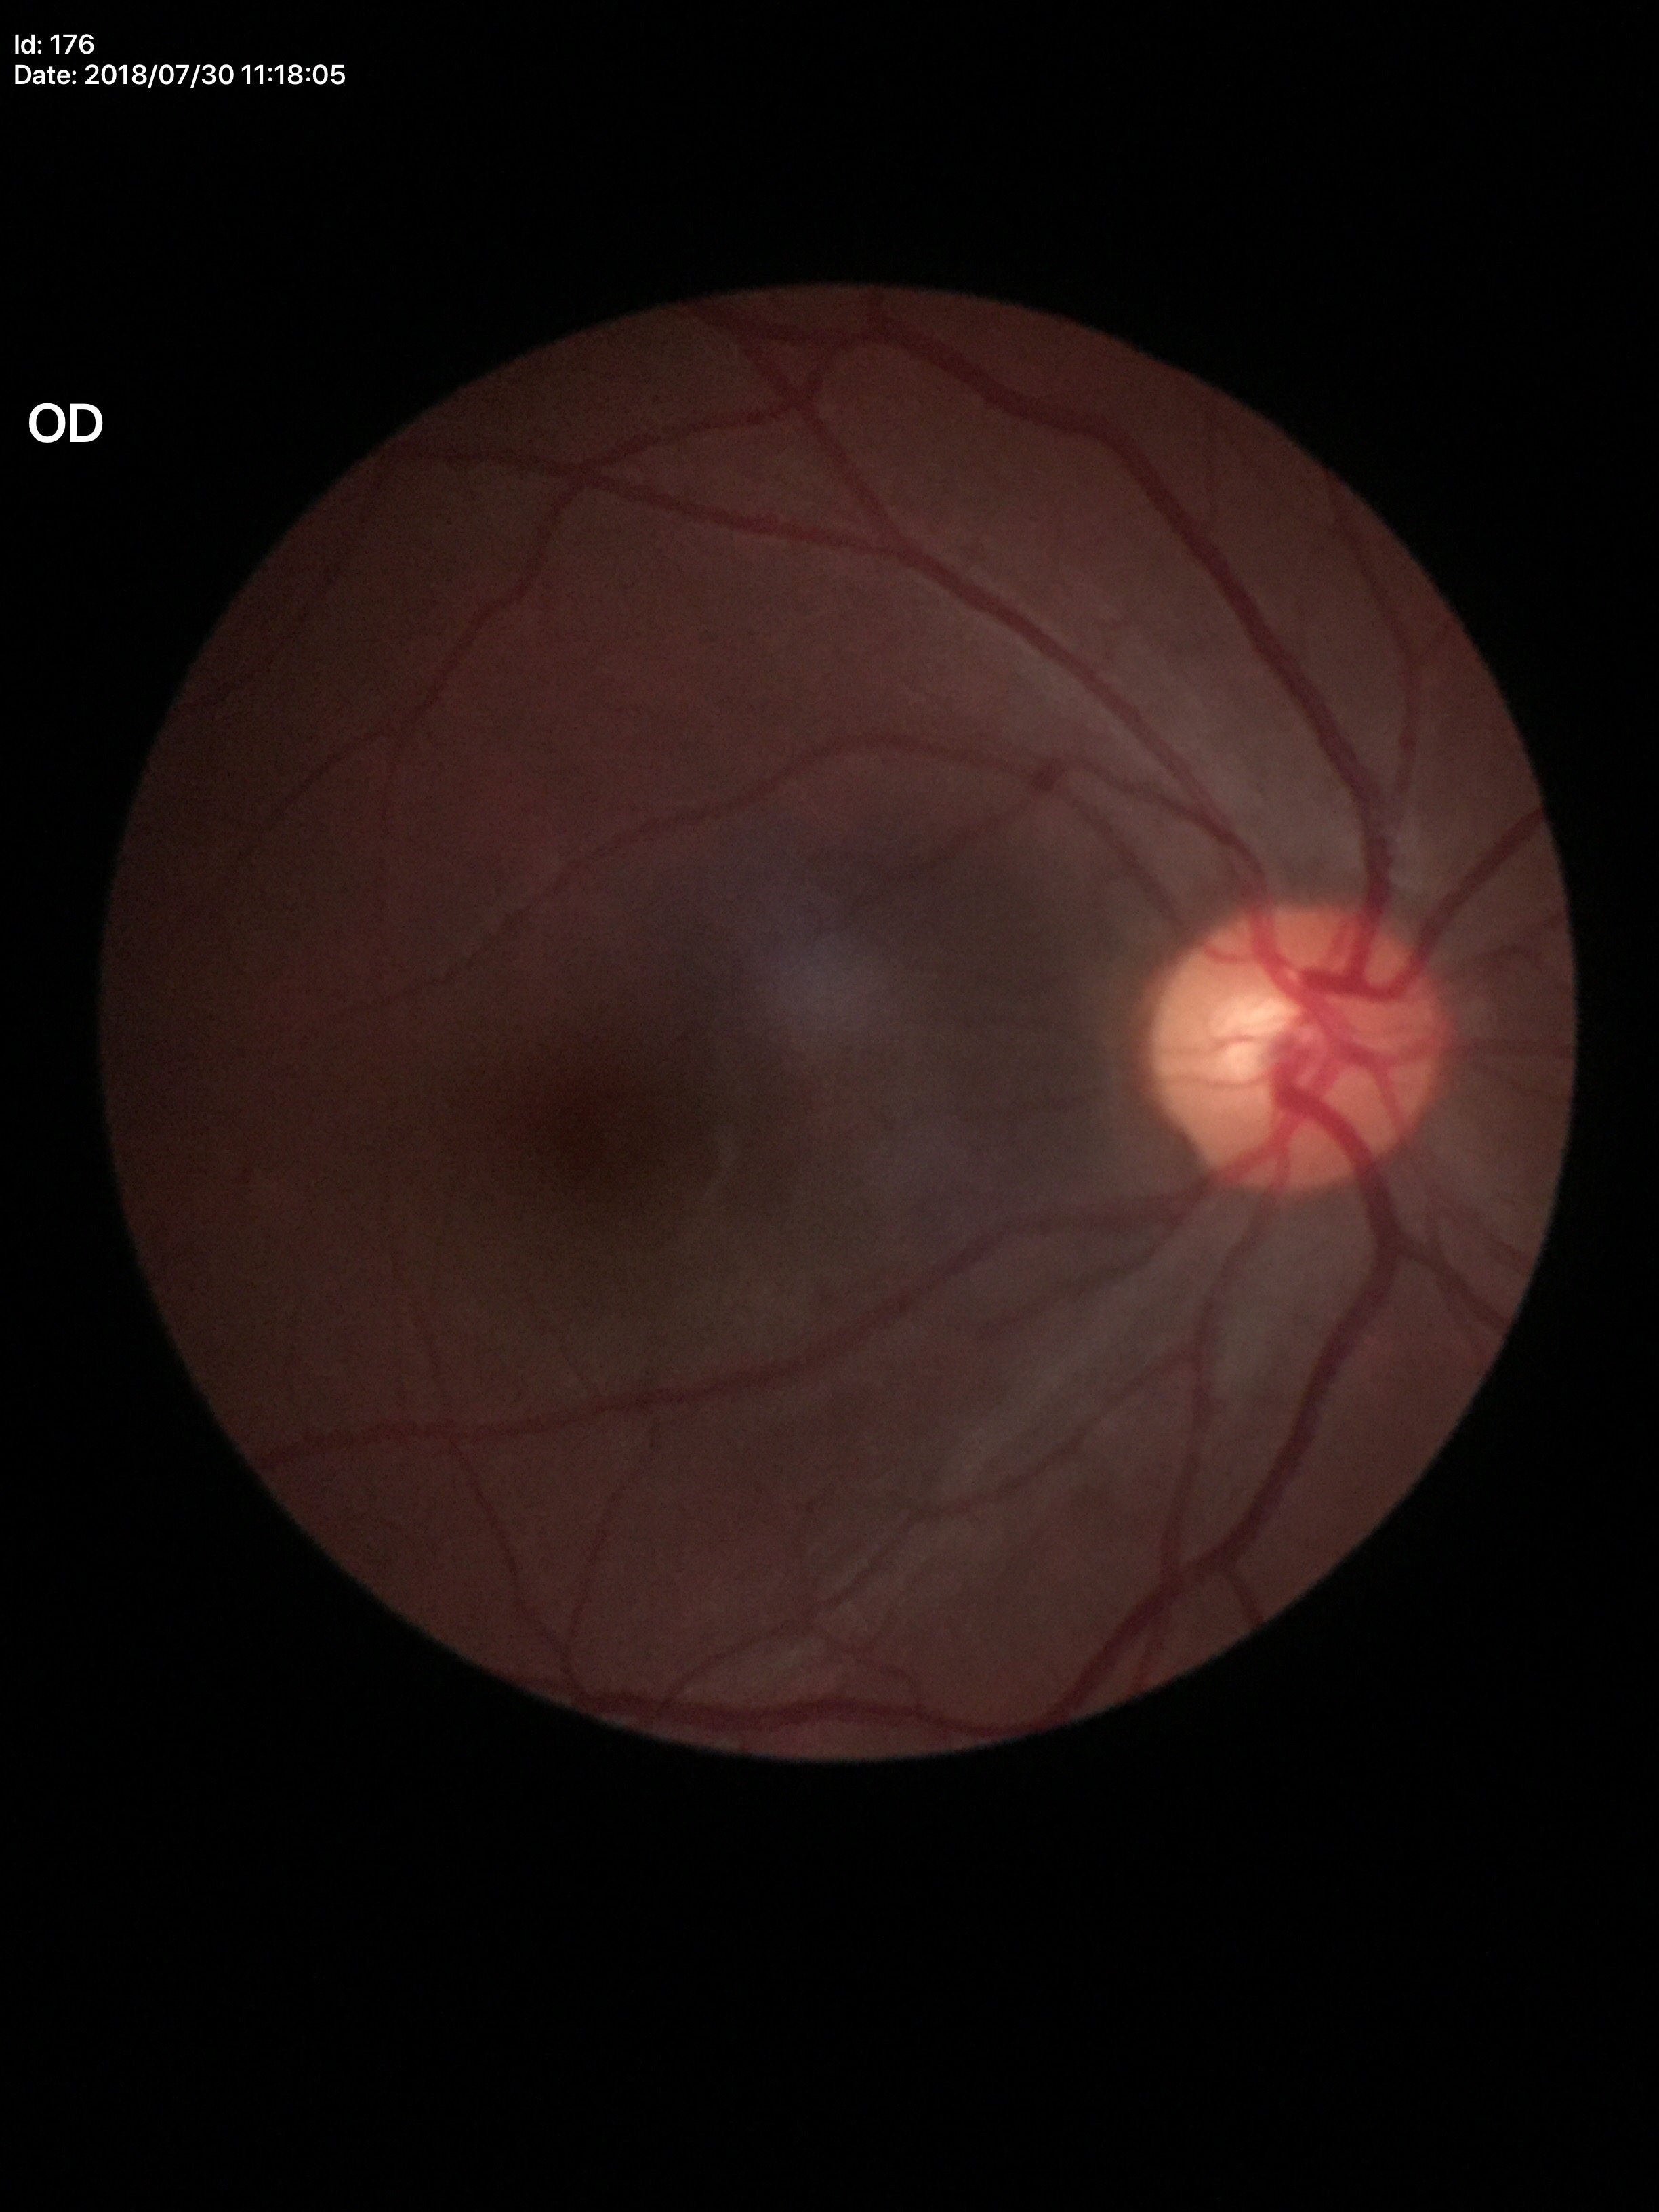 Glaucoma decision: not suspect.
Vertical cup-to-disc ratio (VCDR) is 0.51.
Horizontal cup-disc ratio (HCDR): 0.49.